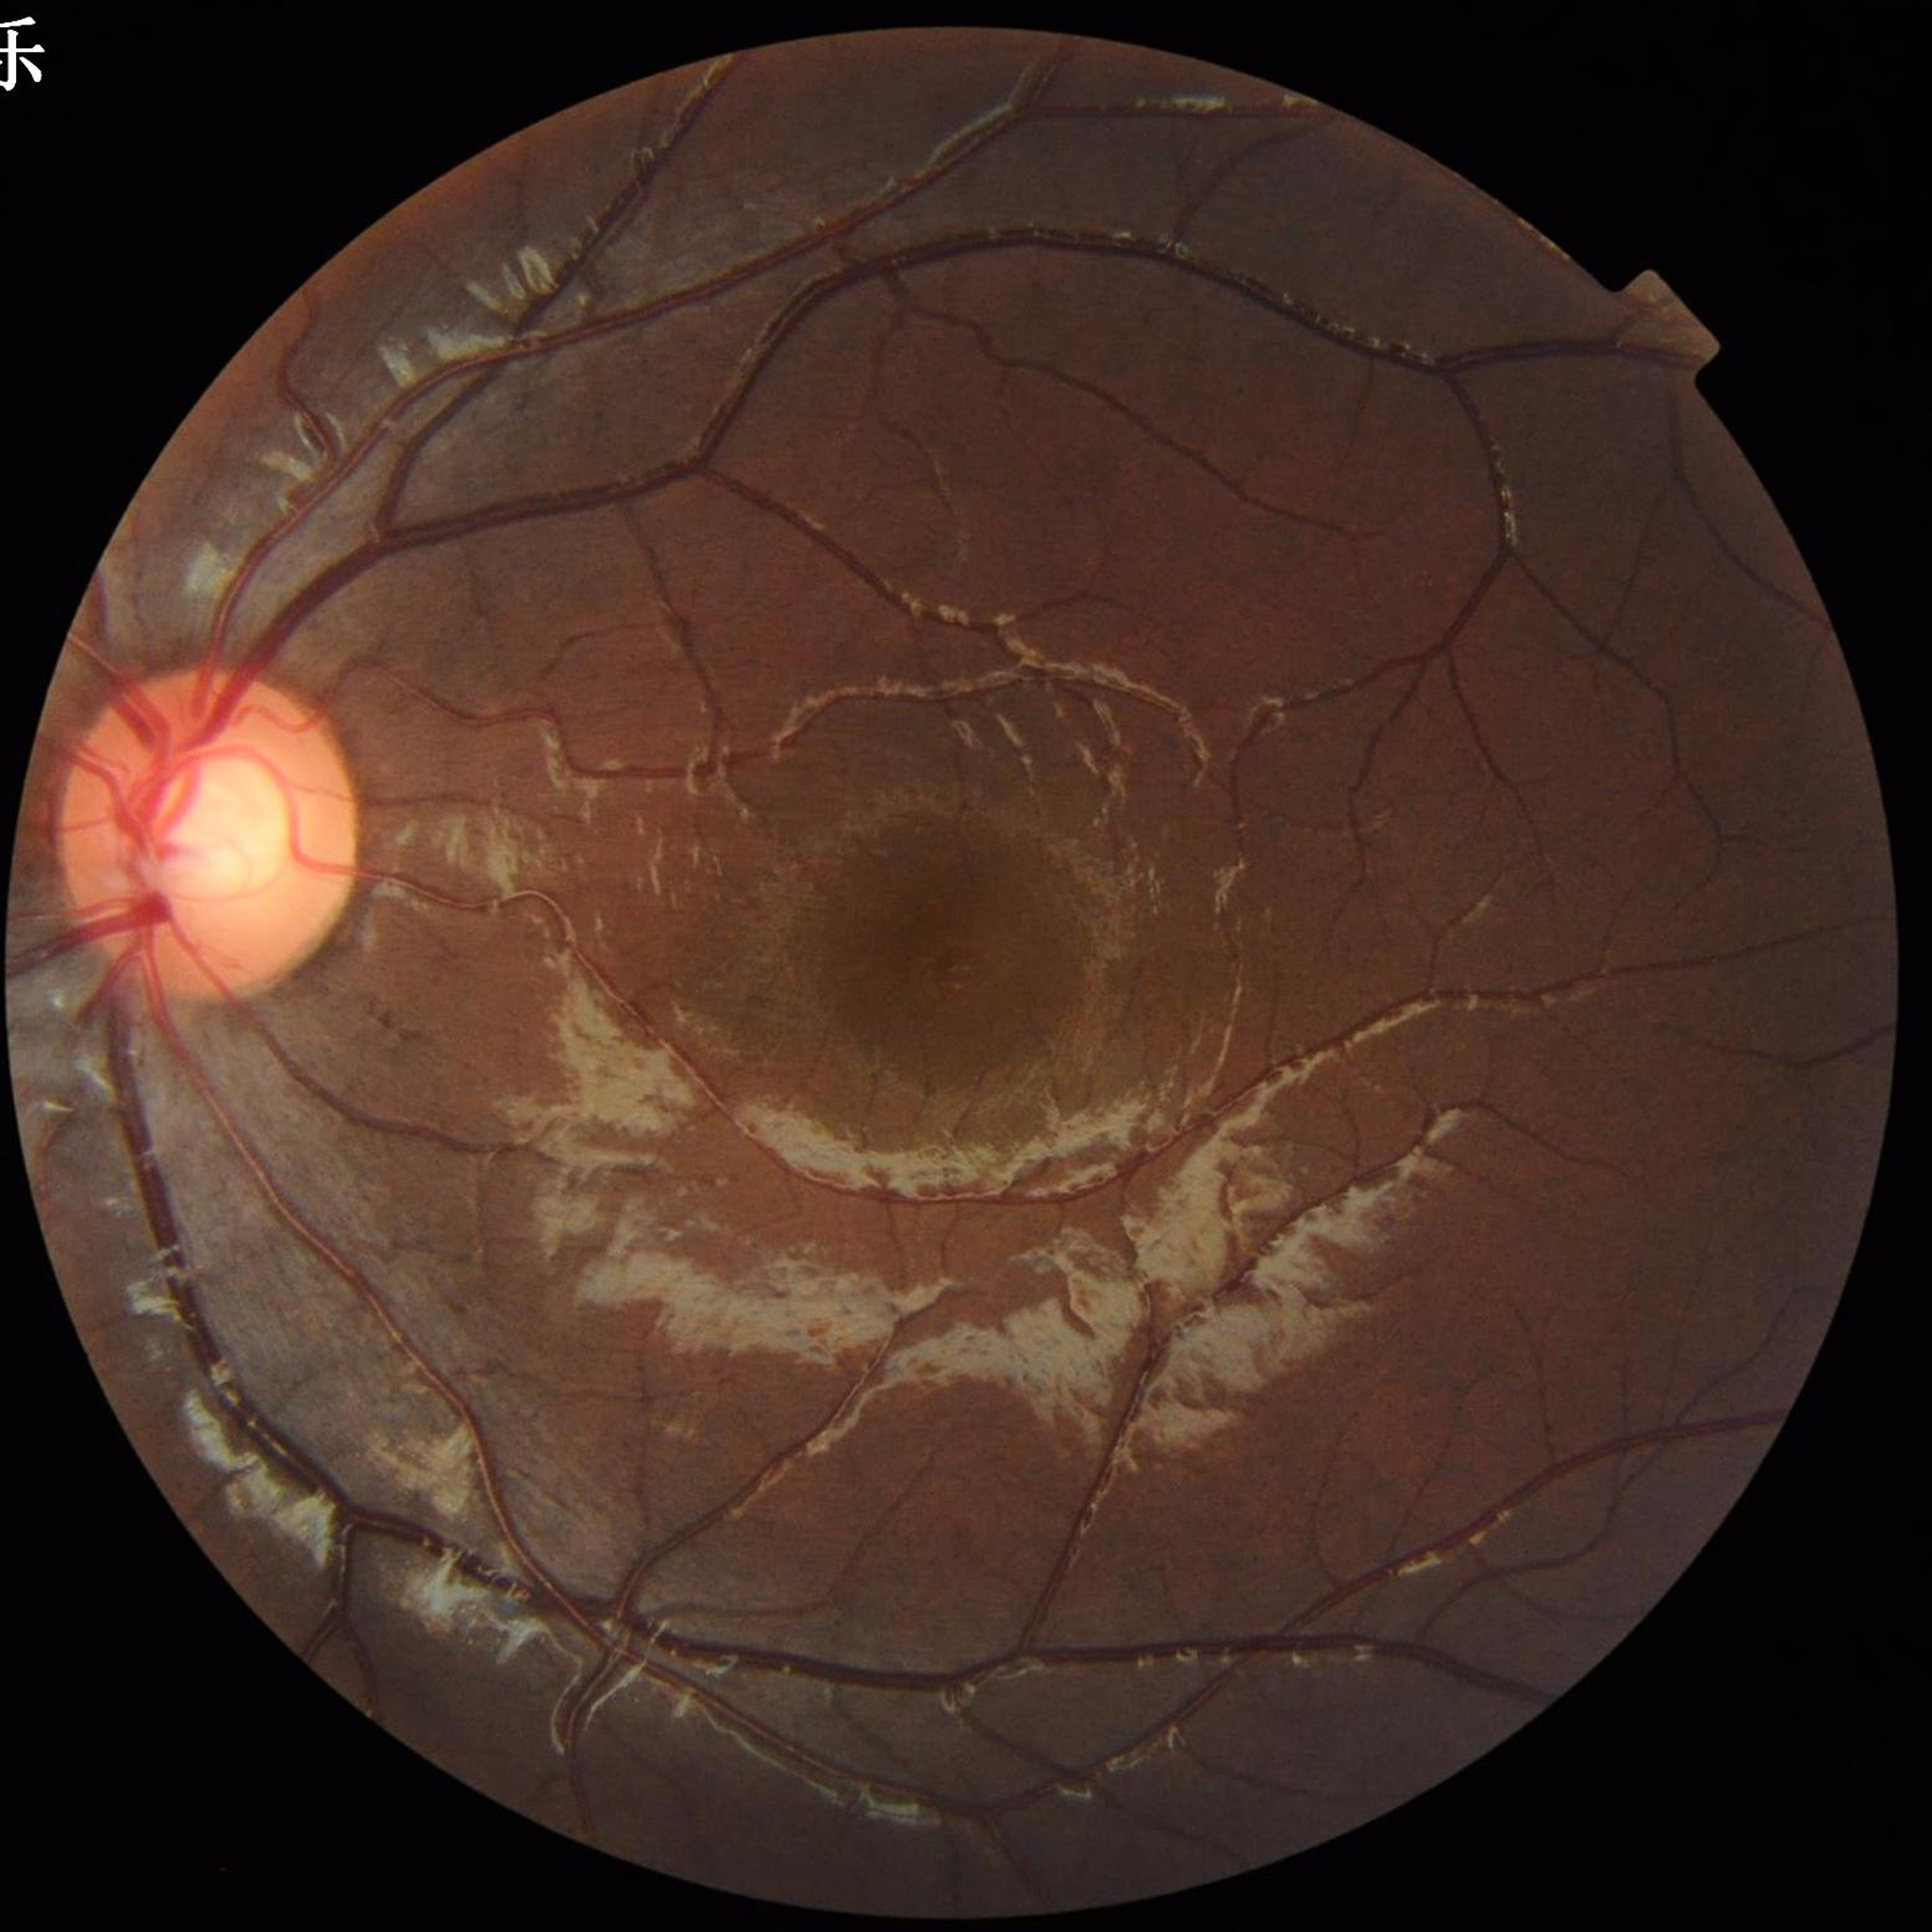 Photo quality: satisfactory.
No findings of AMD, diabetic retinopathy, or glaucoma.